Wide-field fundus photograph of an infant: 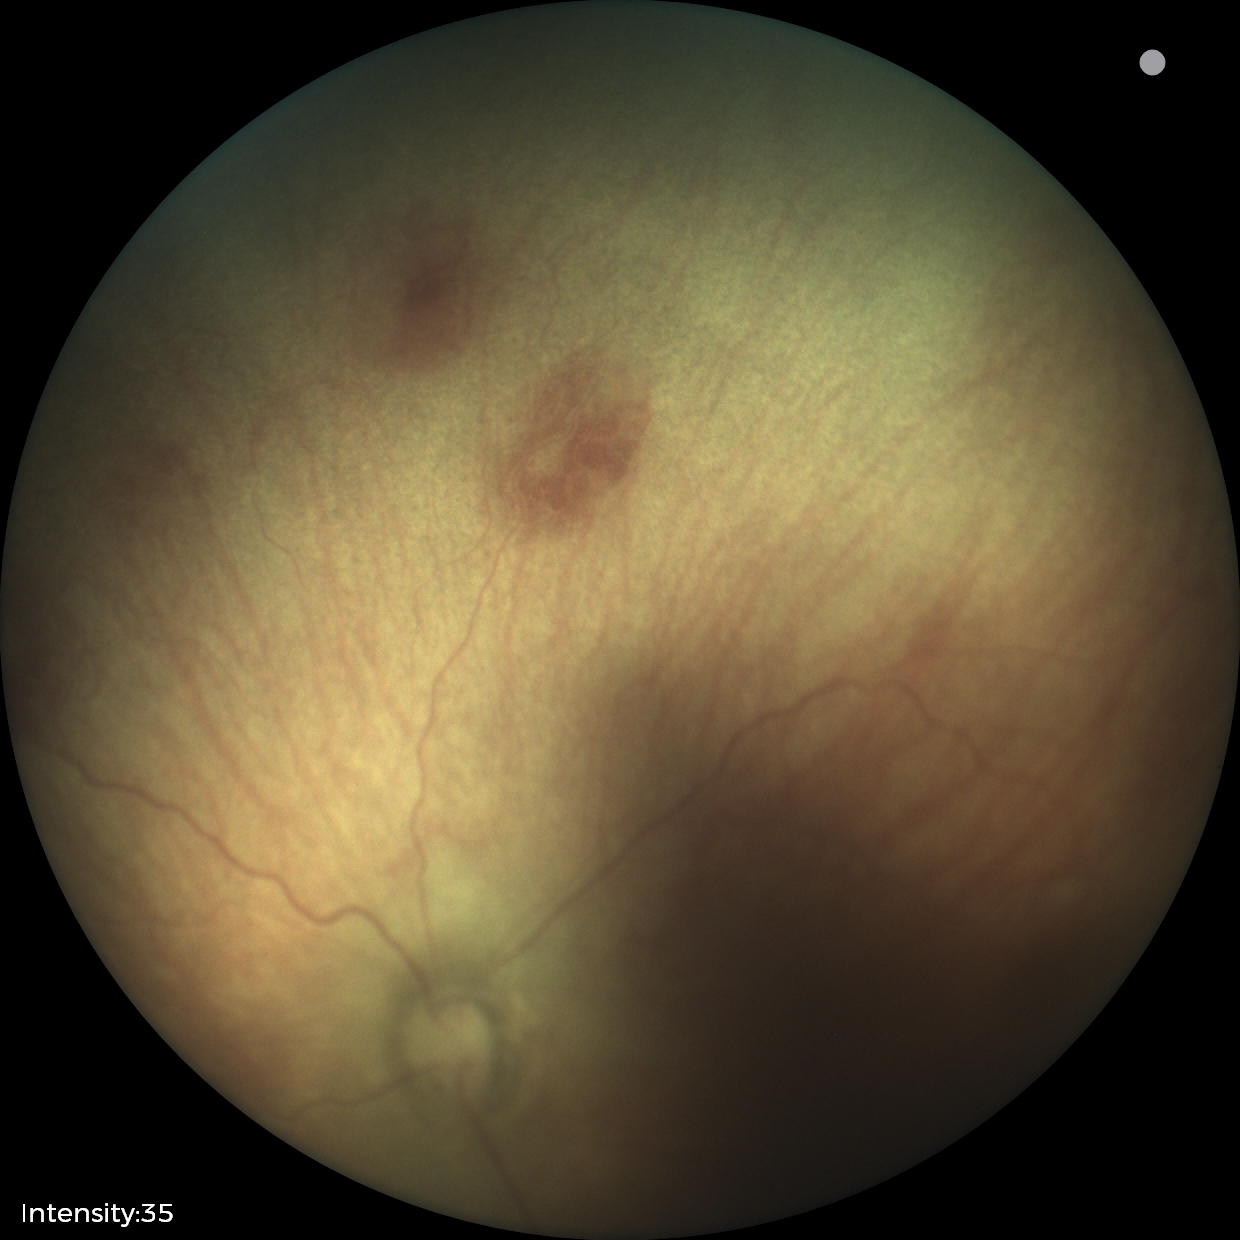
Plus disease absent. Examination diagnosed as retinopathy of prematurity stage 0.